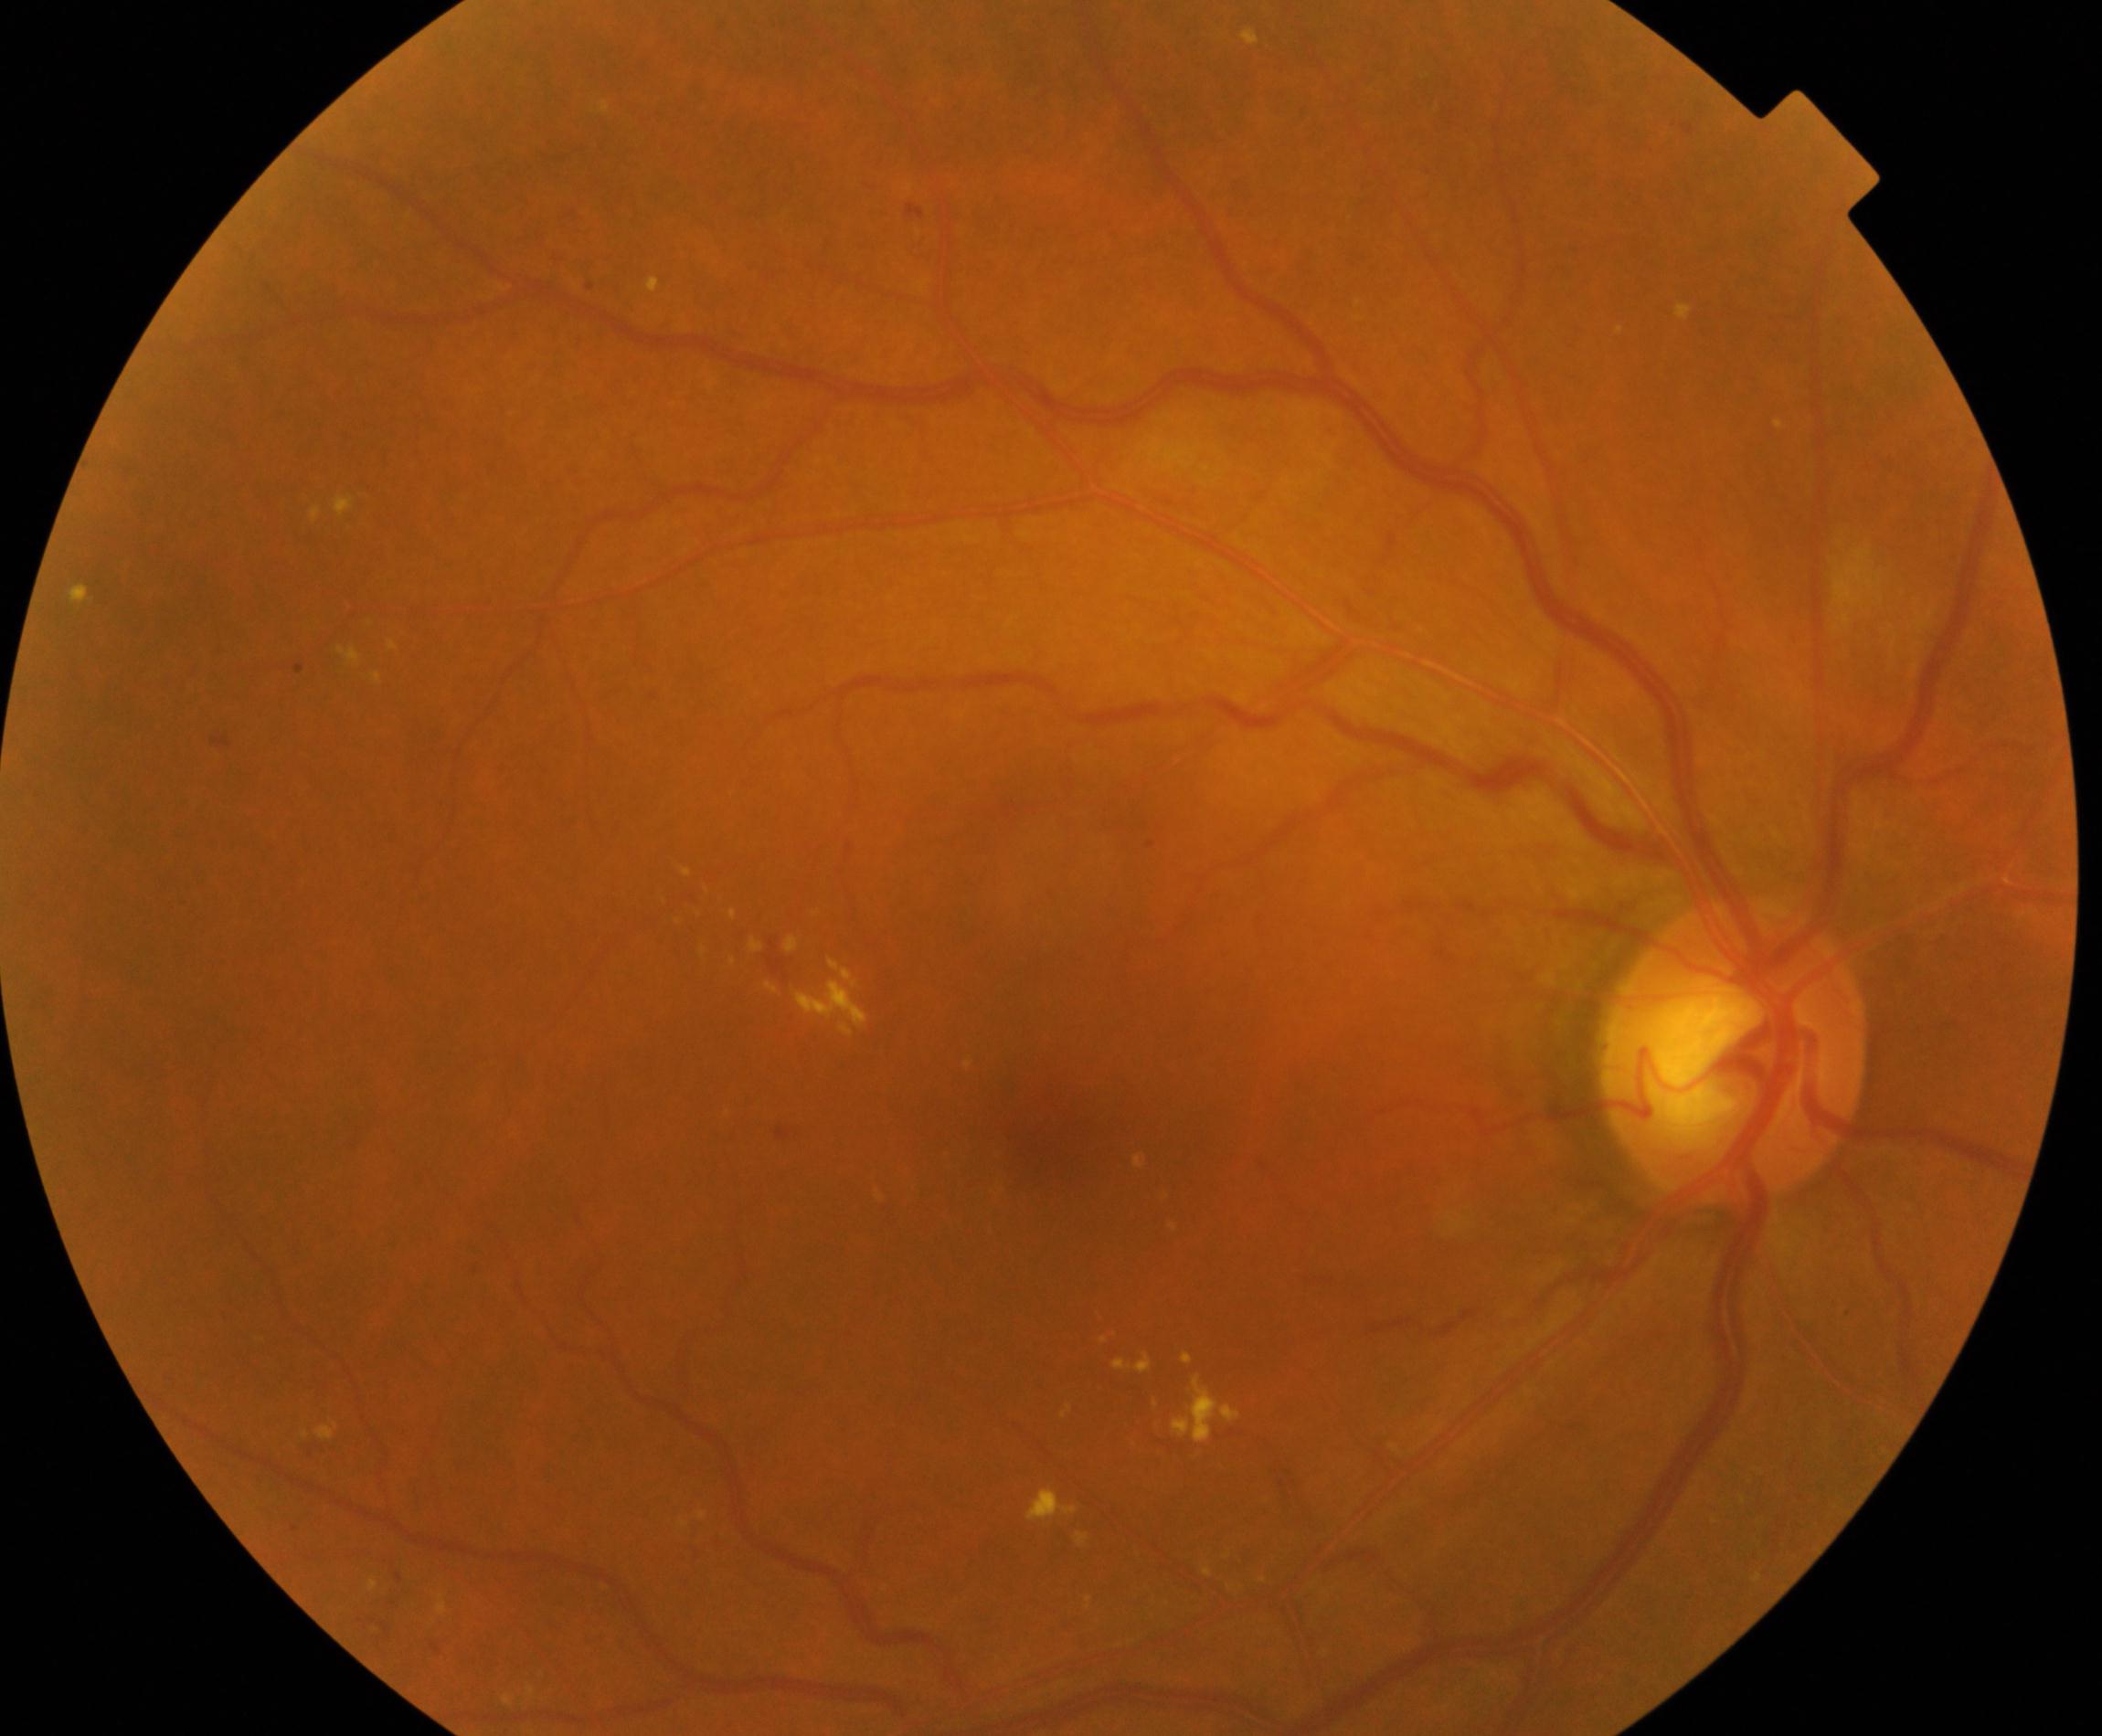
Impression: moderate non-proliferative diabetic retinopathy. Features include microaneurysms with dot and blot hemorrhages or hard exudates, less than severe non-proliferative diabetic retinopathy, and/or with diabetic macular edema.